Modified Davis classification; 848x848; nonmydriatic fundus photograph:
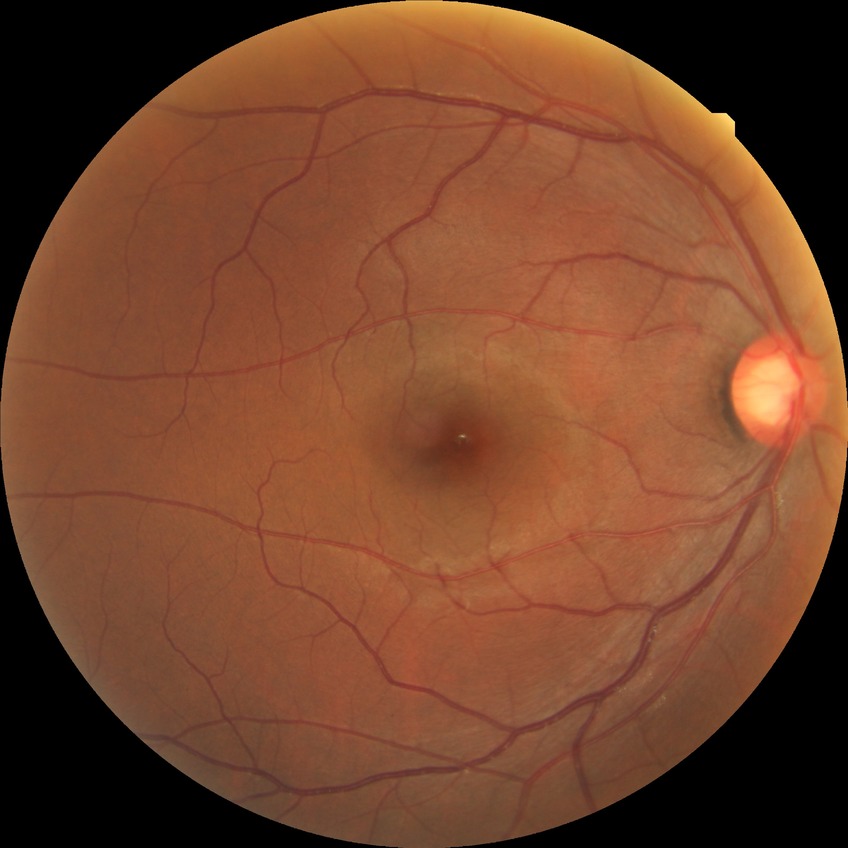

Diabetic retinopathy (DR): no diabetic retinopathy (NDR).